Retinal fundus photograph:
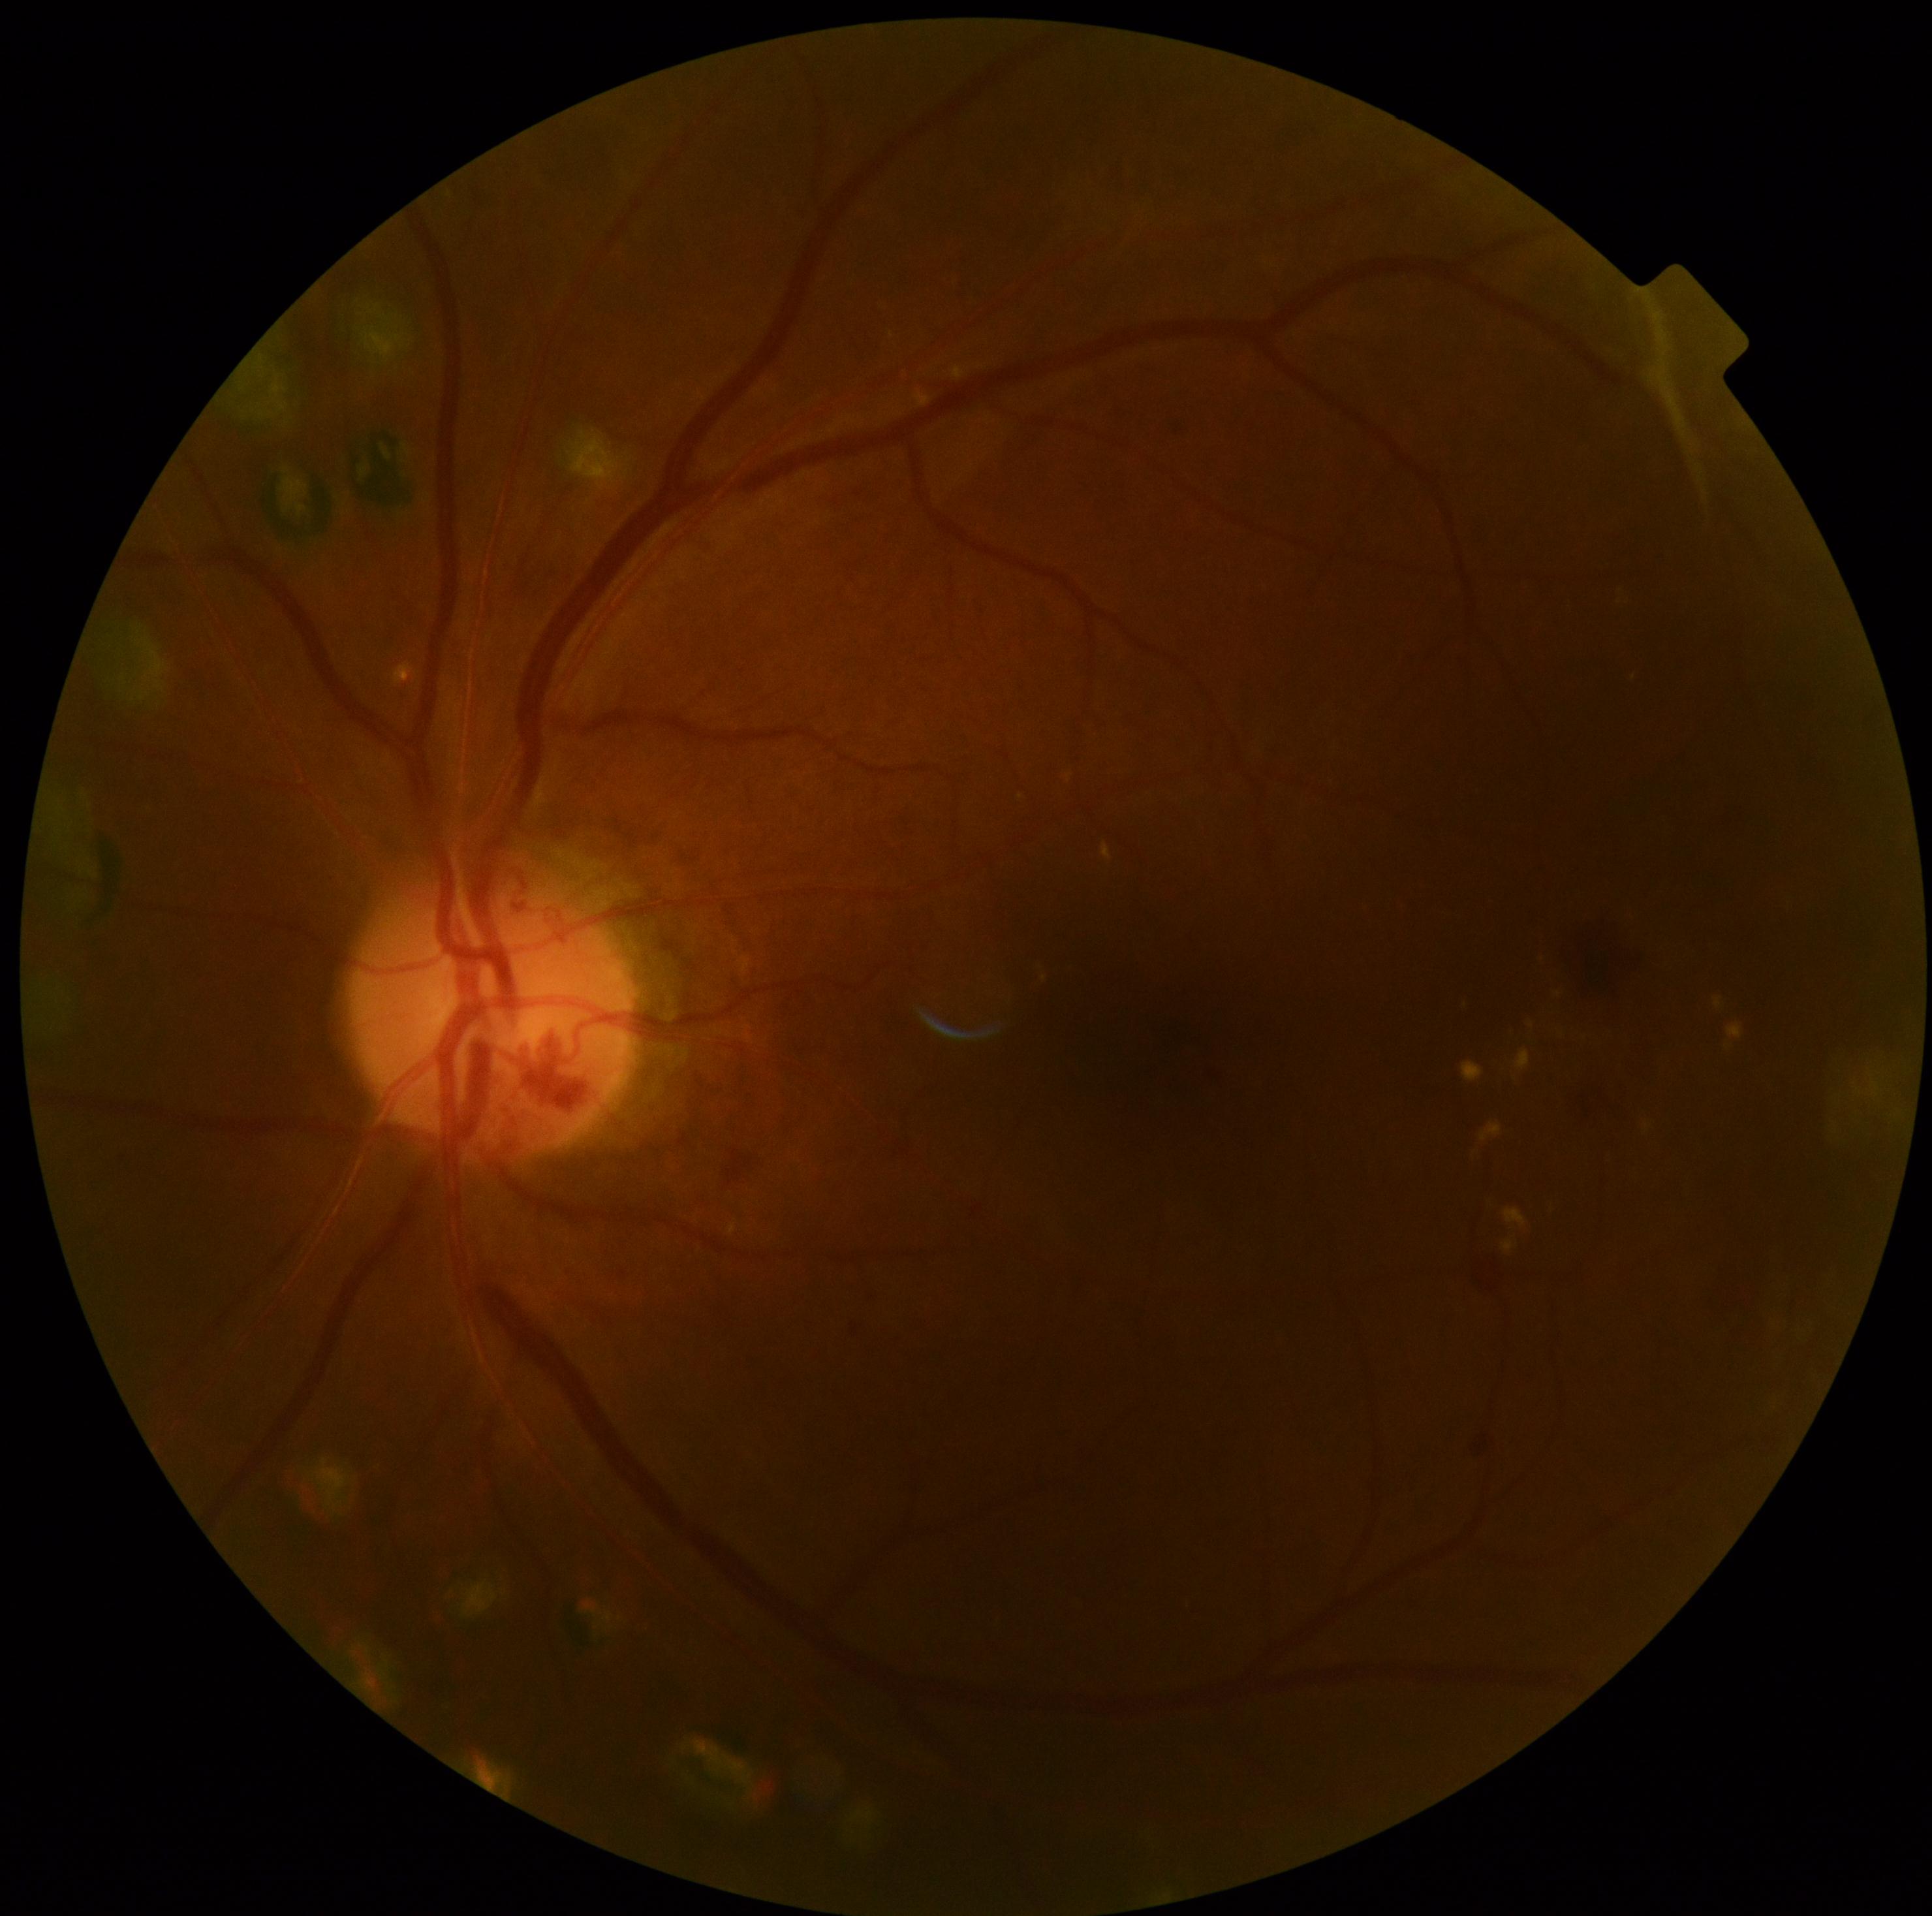
– DR severity: 4